Image size 1440x1080; pediatric retinal photograph (wide-field):
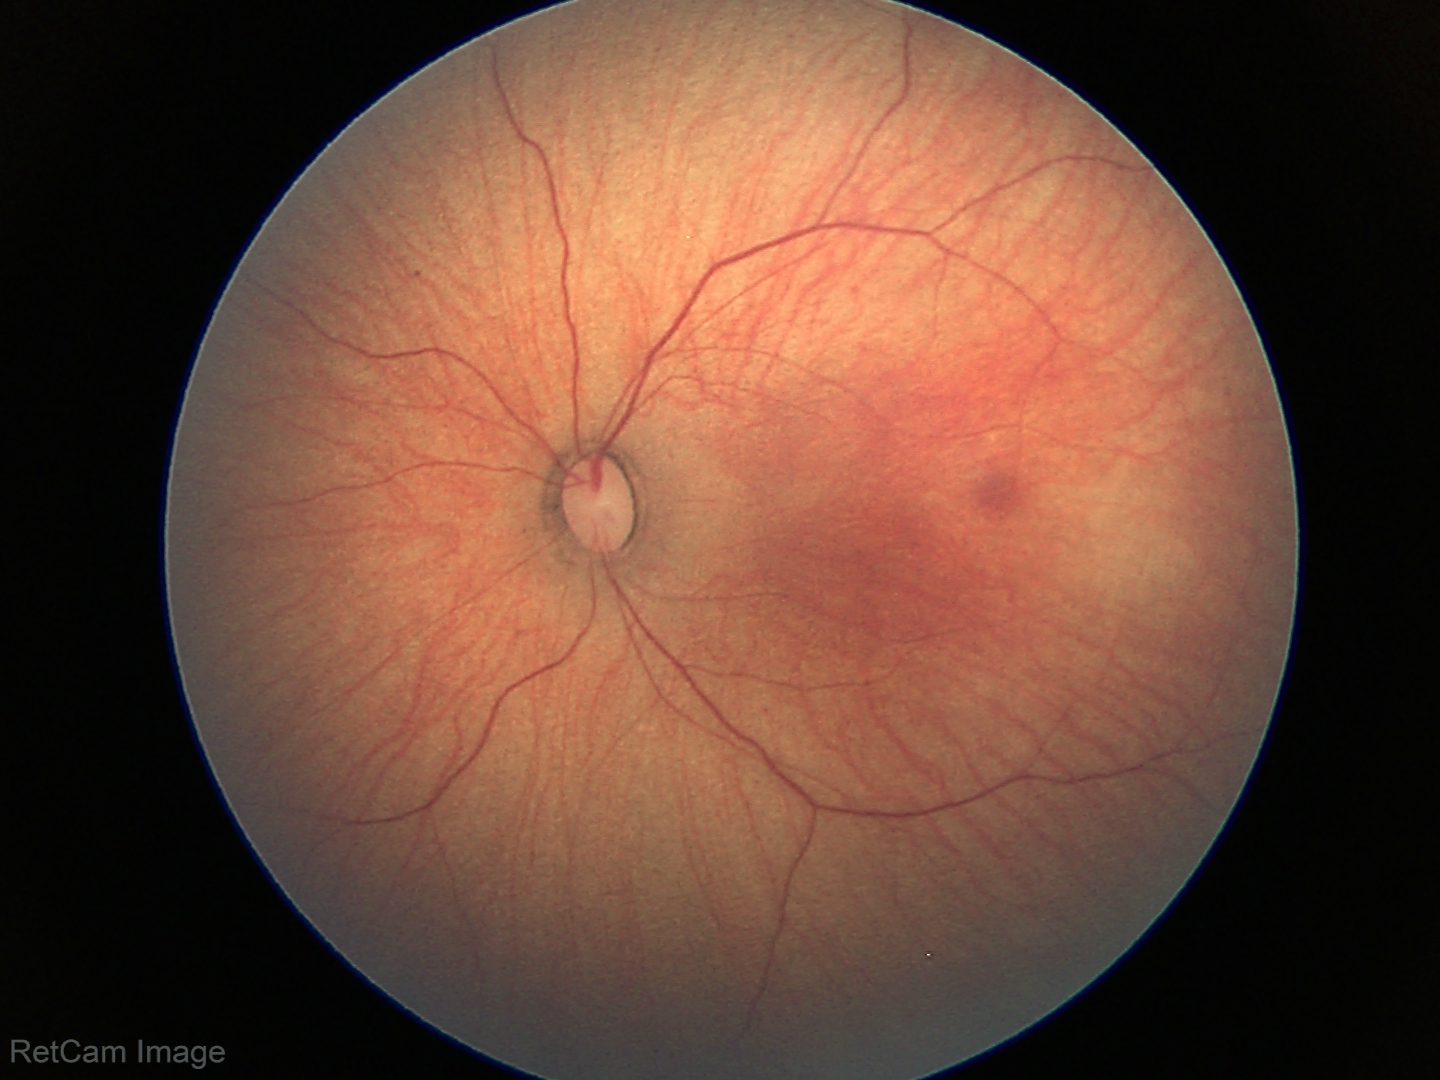
Diagnosis: normal retinal appearance.